FOV: 45 degrees · retinal fundus photograph.
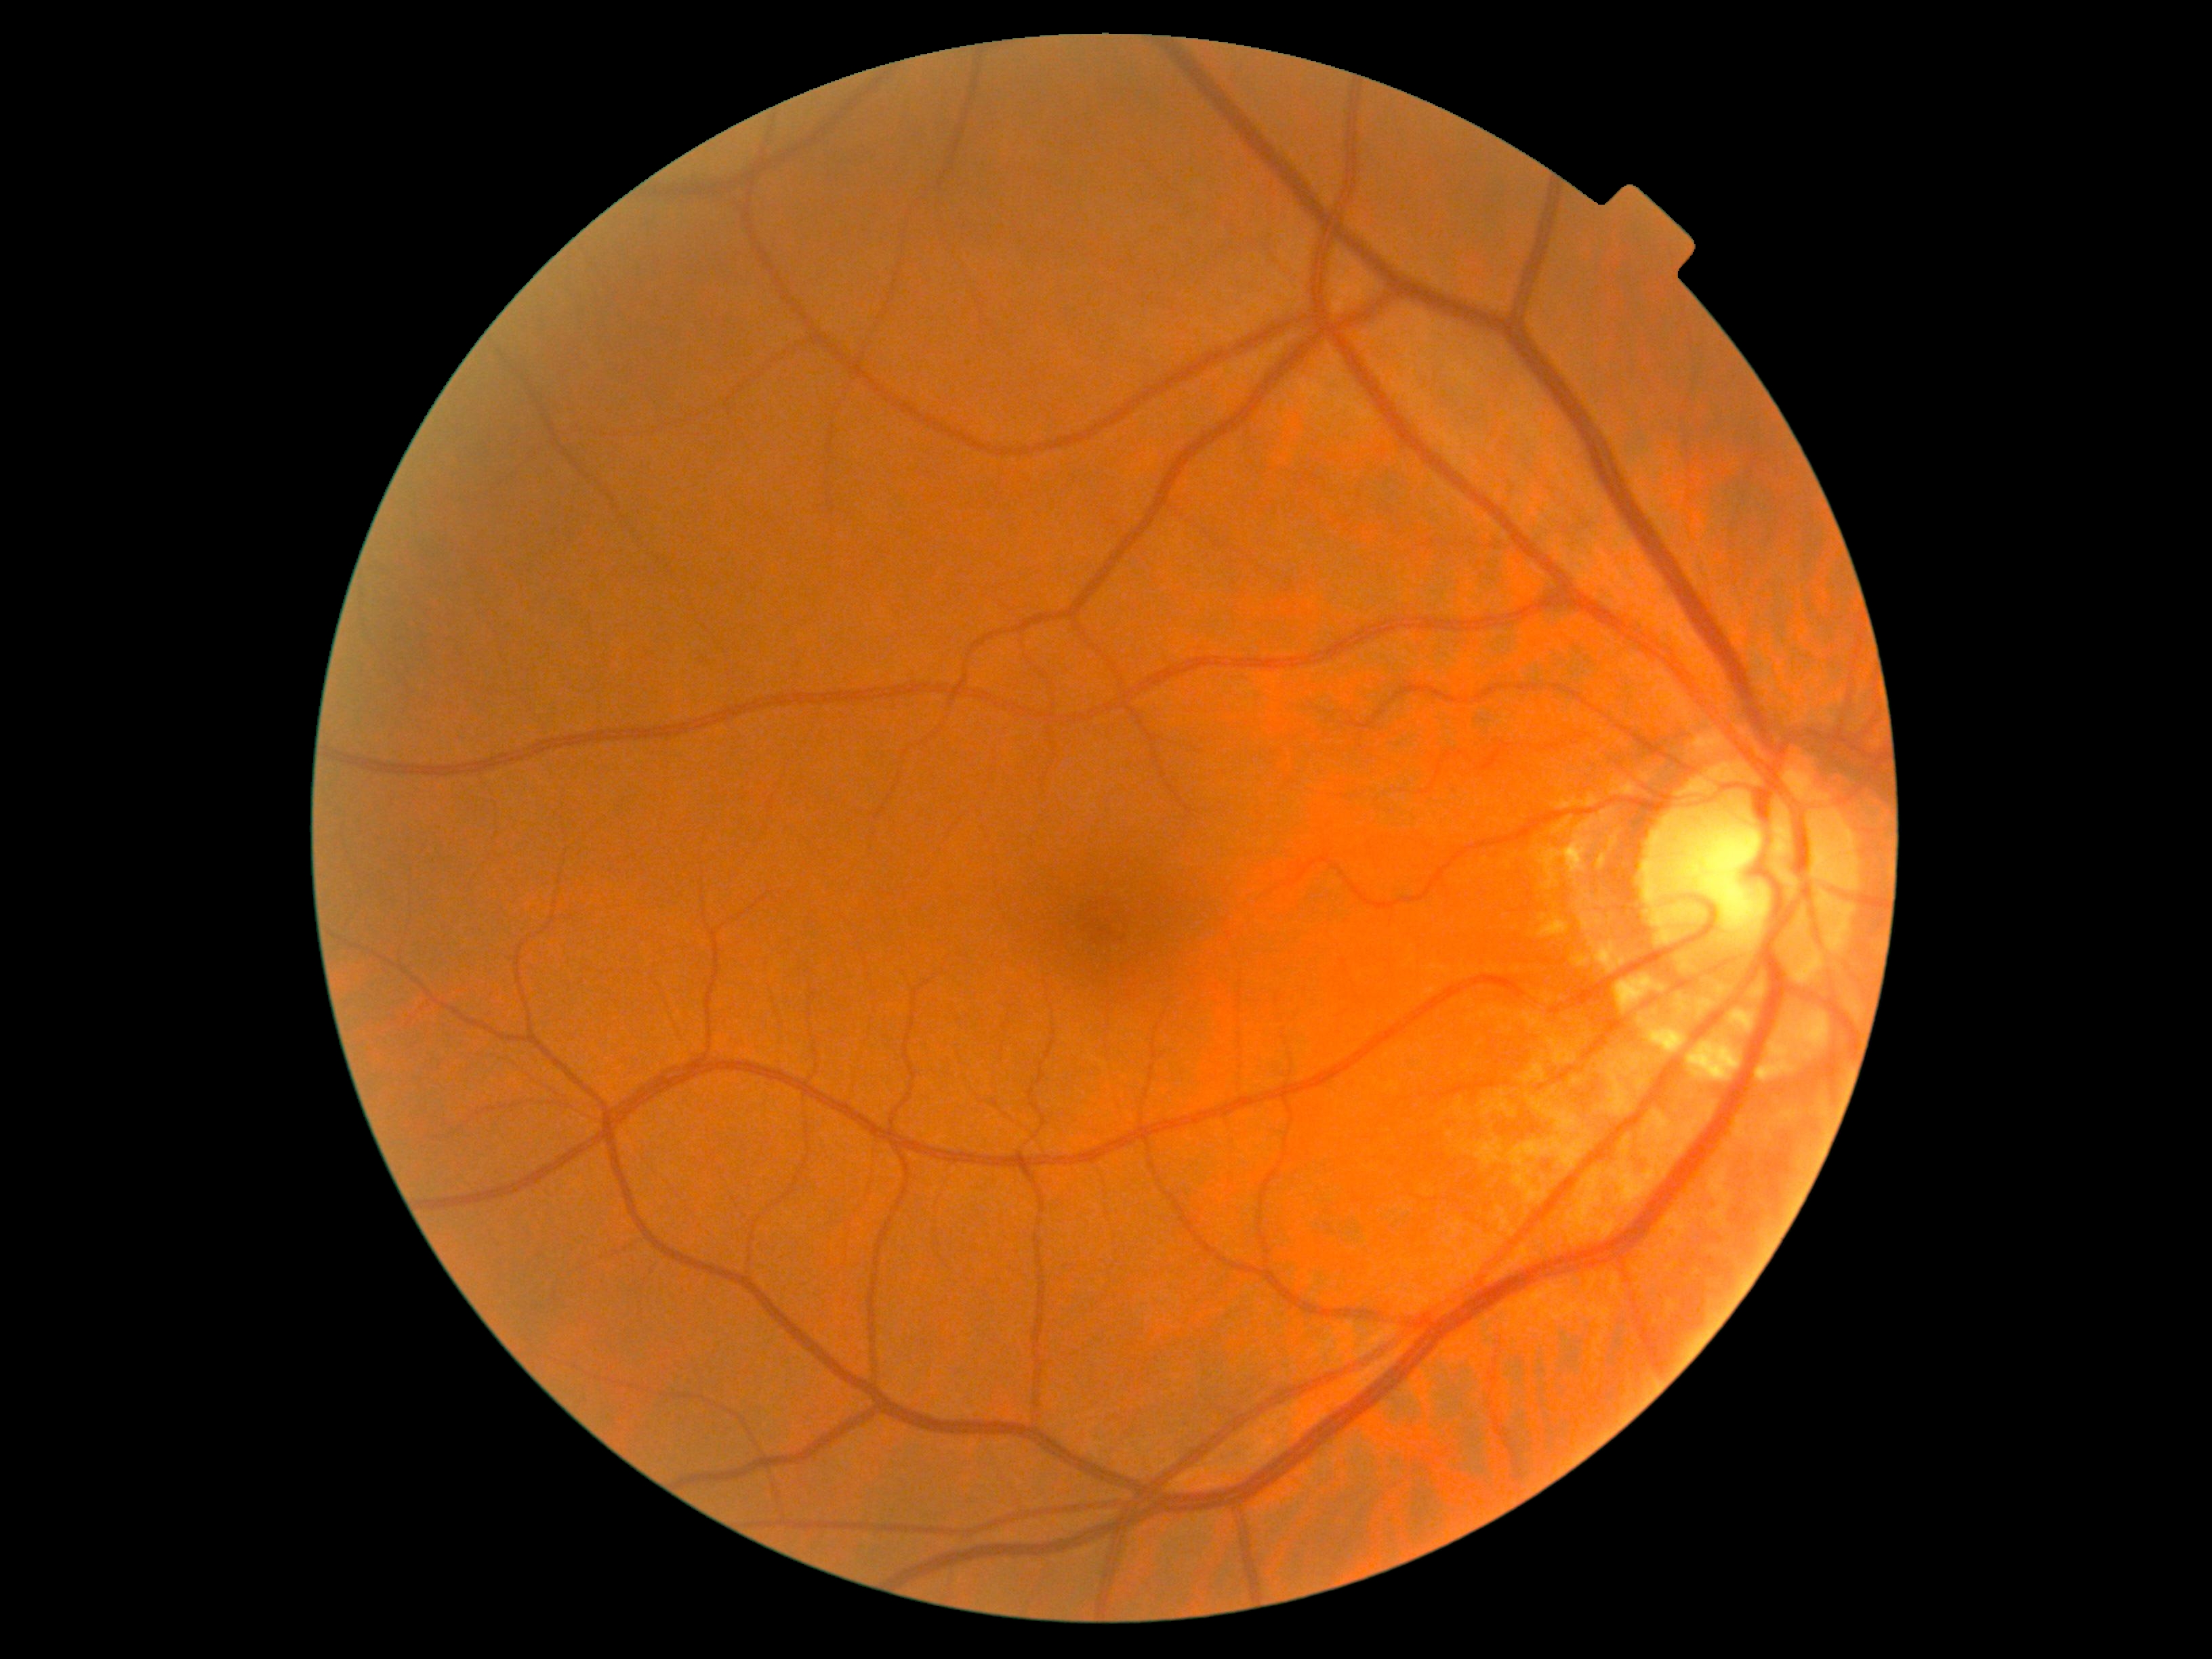

{"dr_grade": "0"}